Acquired with a NIDEK AFC-230, 45 degree fundus photograph, CFP, nonmydriatic — 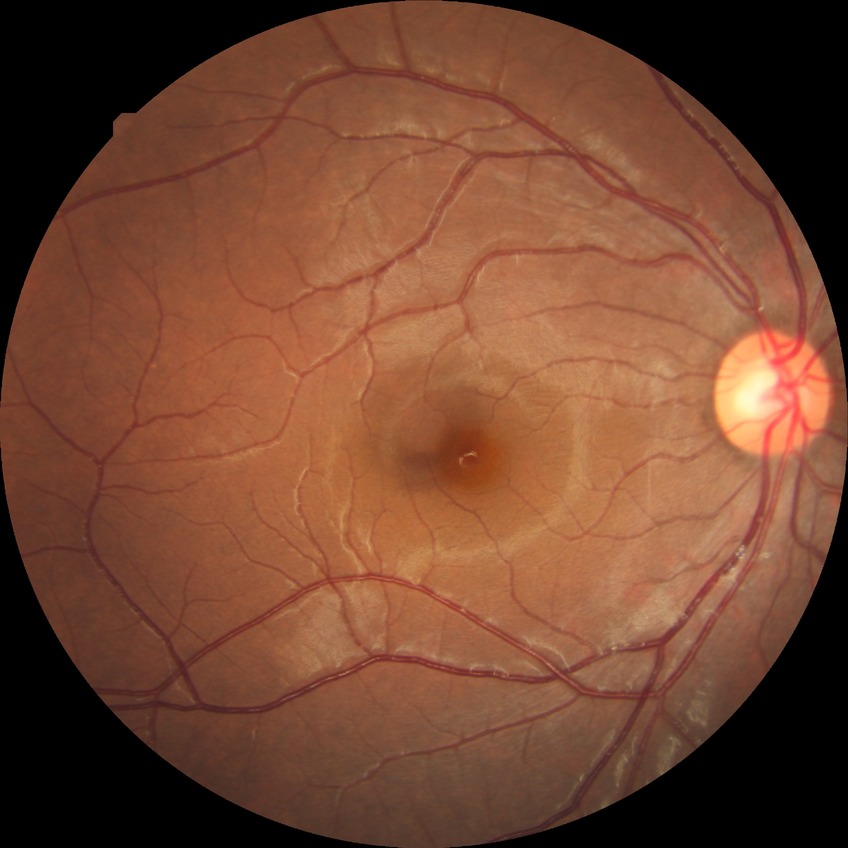
{
  "davis_grade": "NDR"
}